Phoenix ICON wide-field infant fundus image. 1240x1240. Camera: Phoenix ICON (100° FOV).
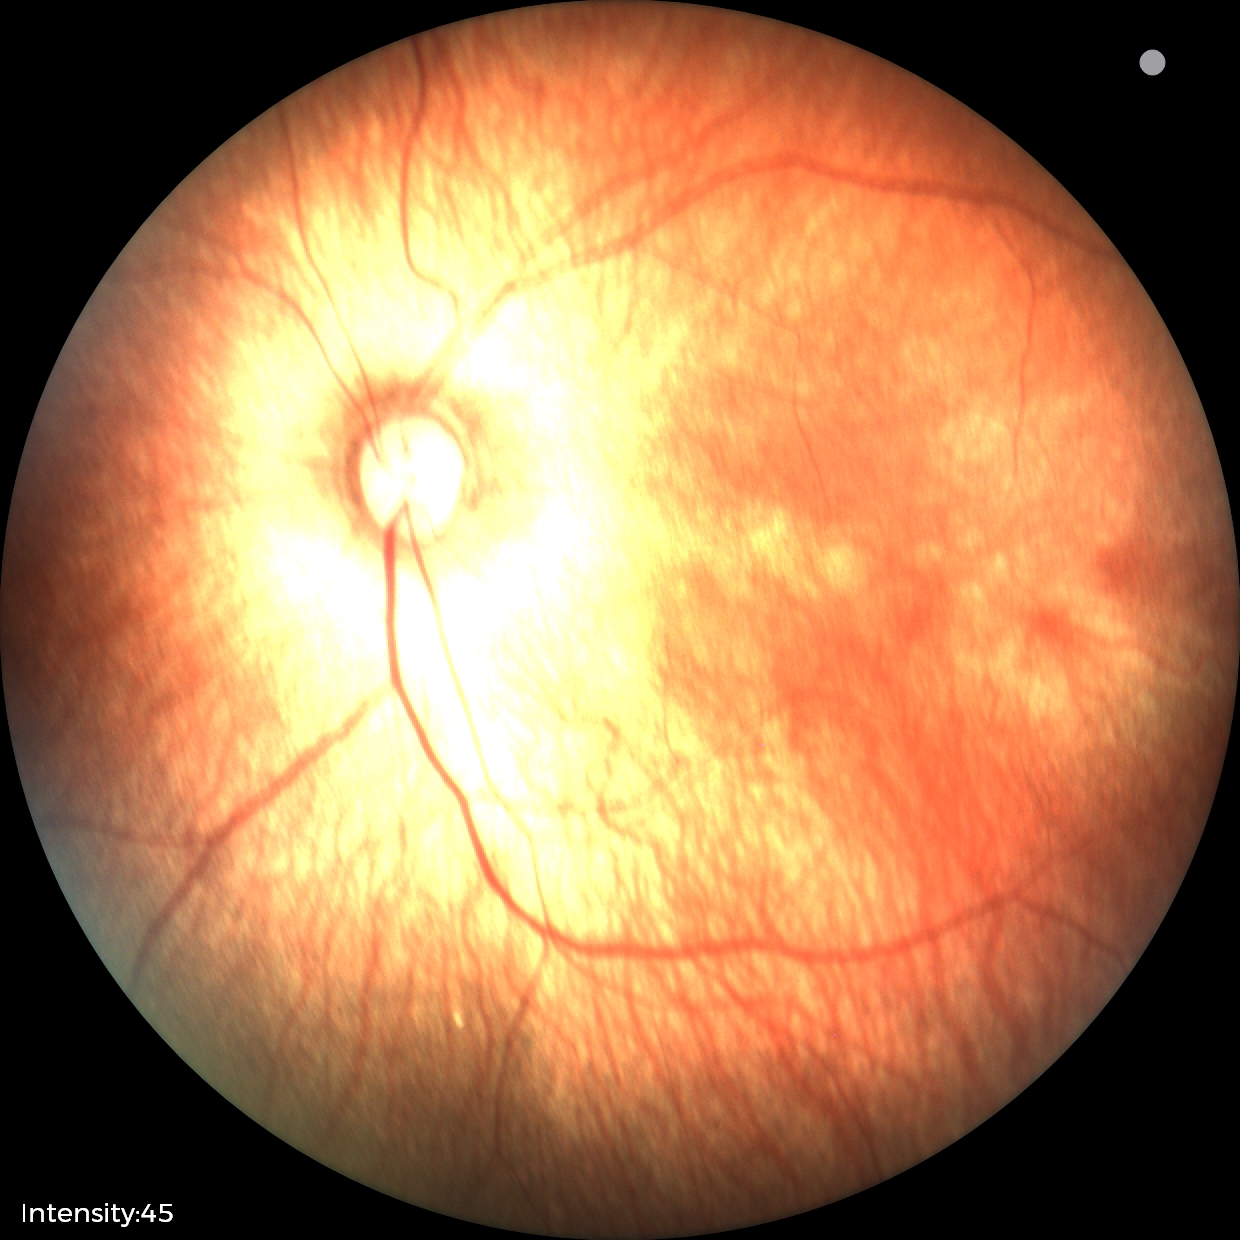
Normal screening examination.